Color fundus photograph · image size 2352x1568
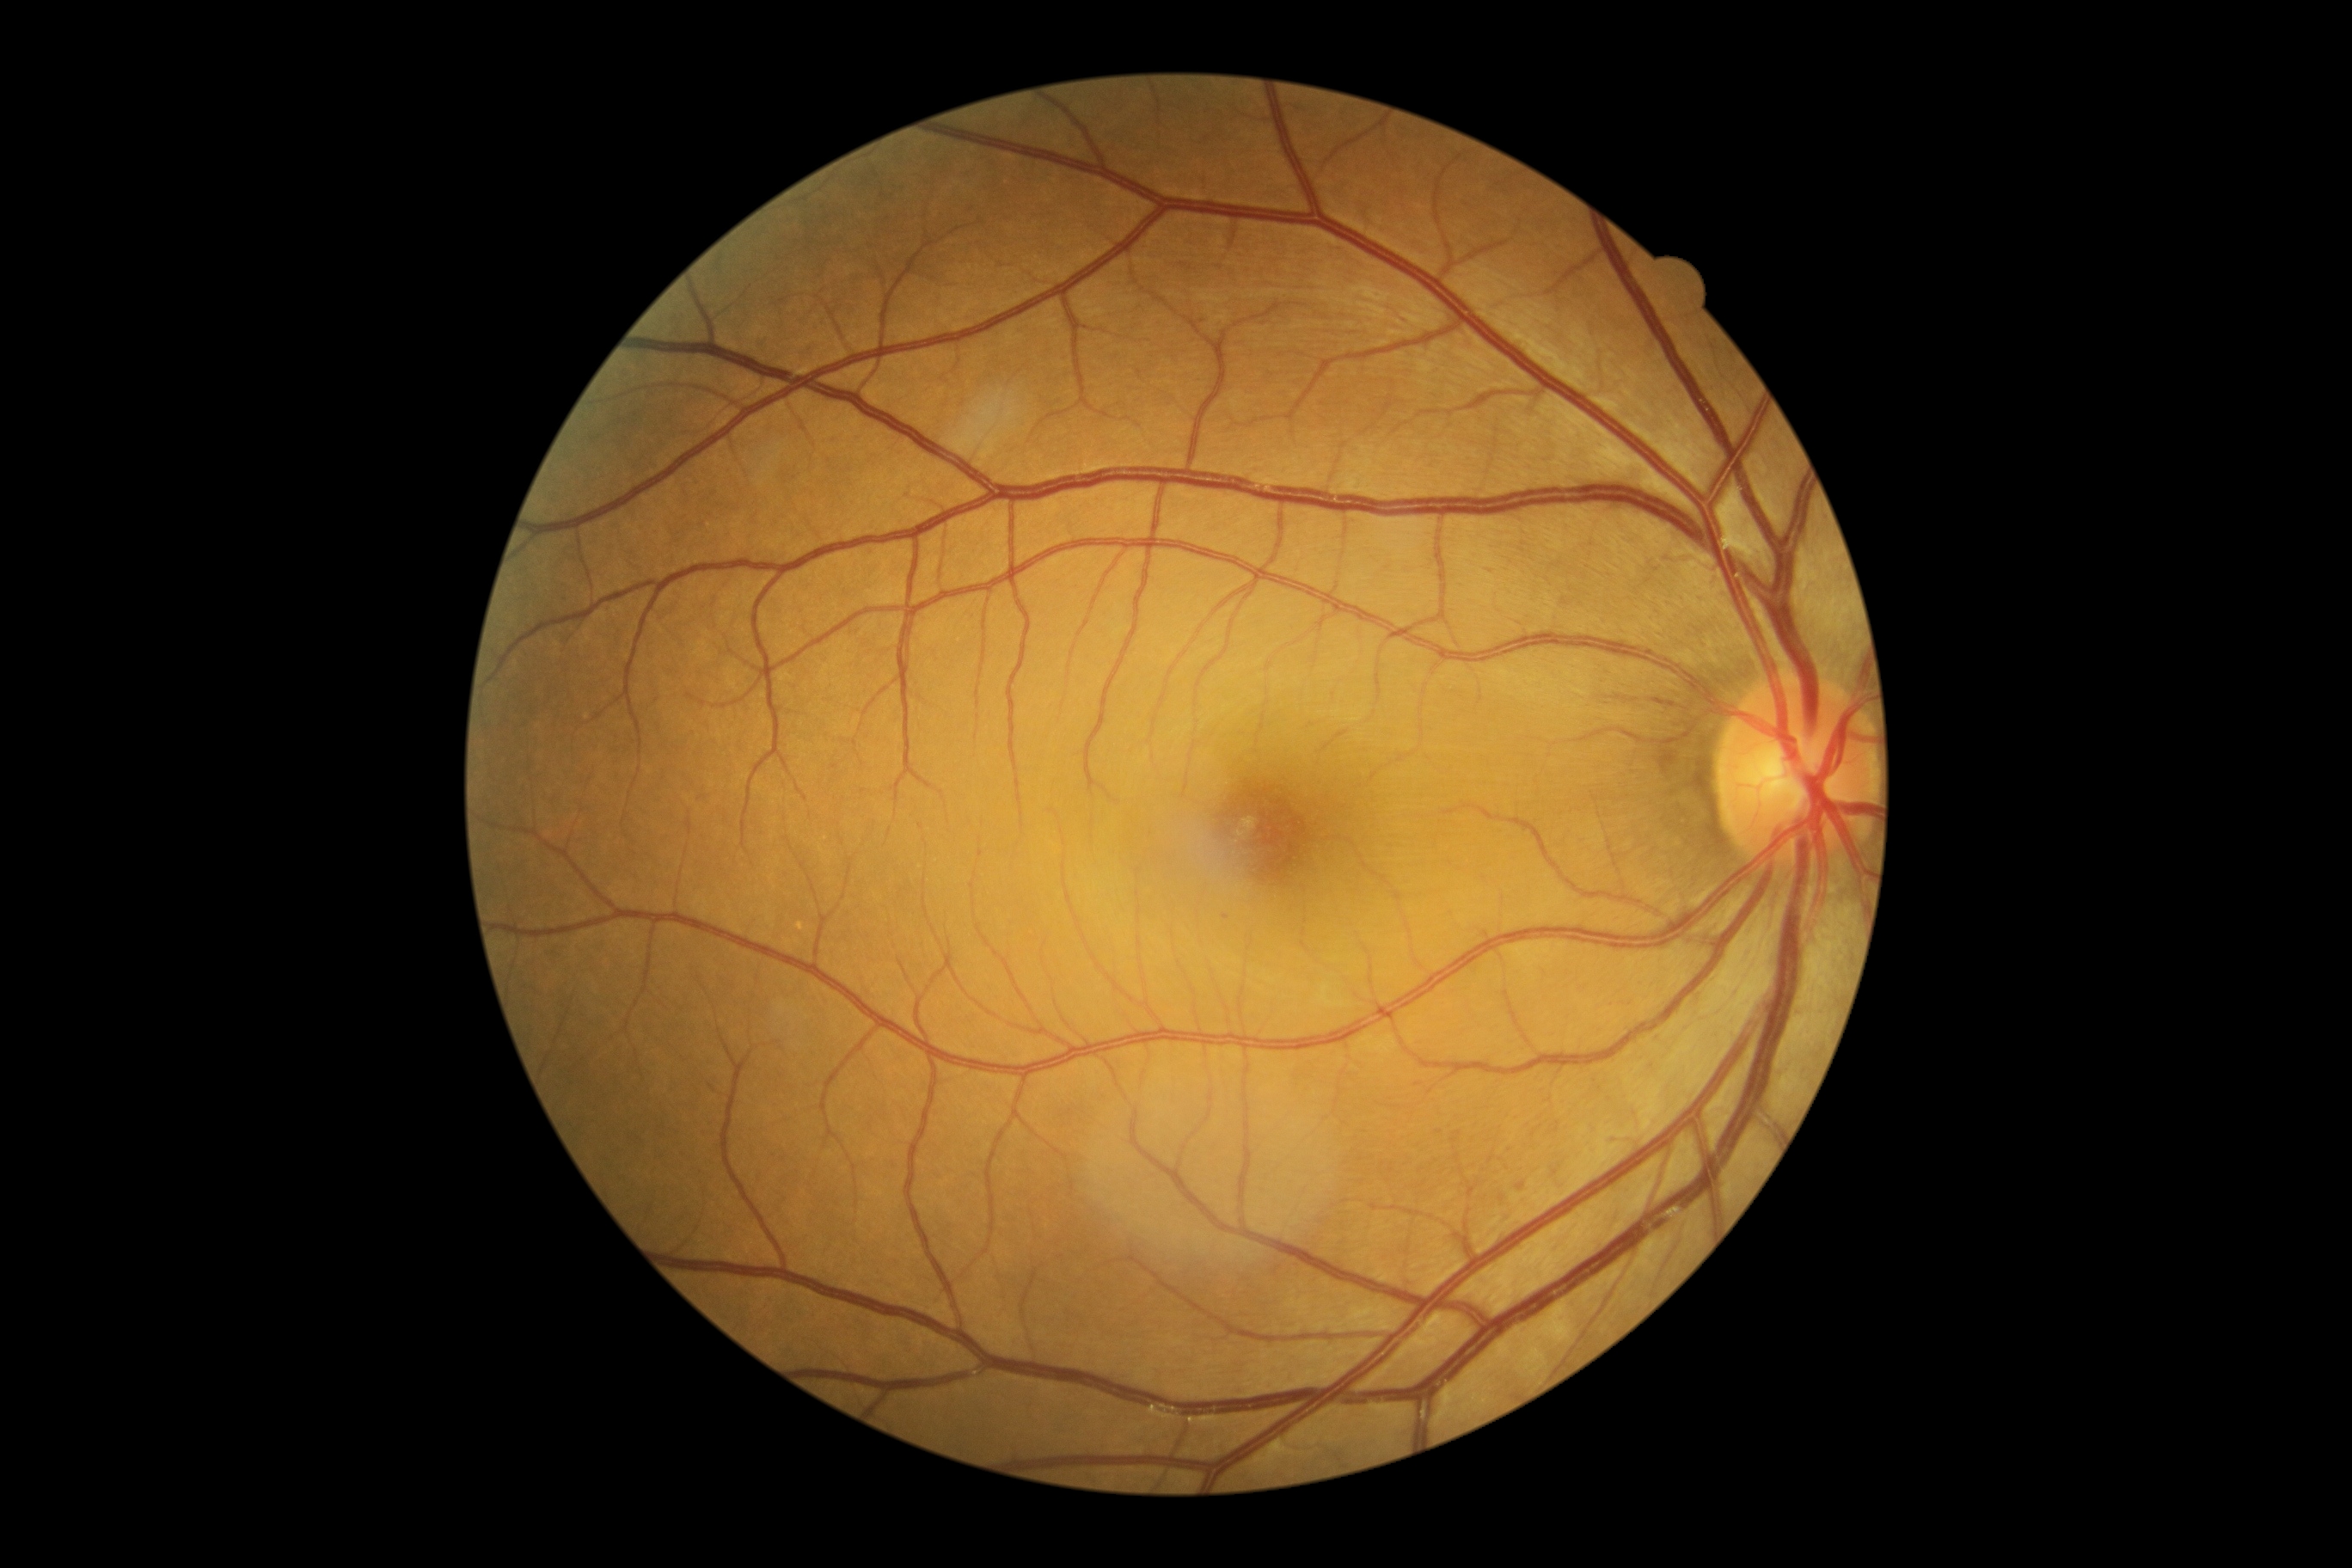 DR severity: grade 1 (mild NPDR).